NIDEK AFC-230 · DR severity per modified Davis staging:
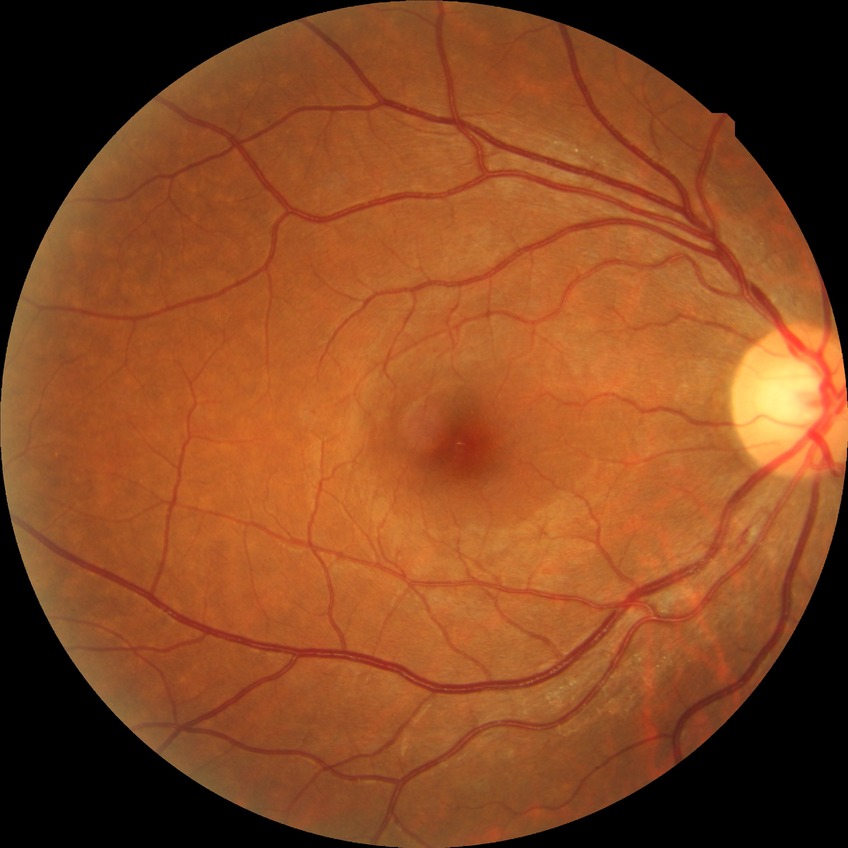

  davis_grade: simple diabetic retinopathy